Camera: Phoenix ICON (100° FOV). Pediatric retinal photograph (wide-field).
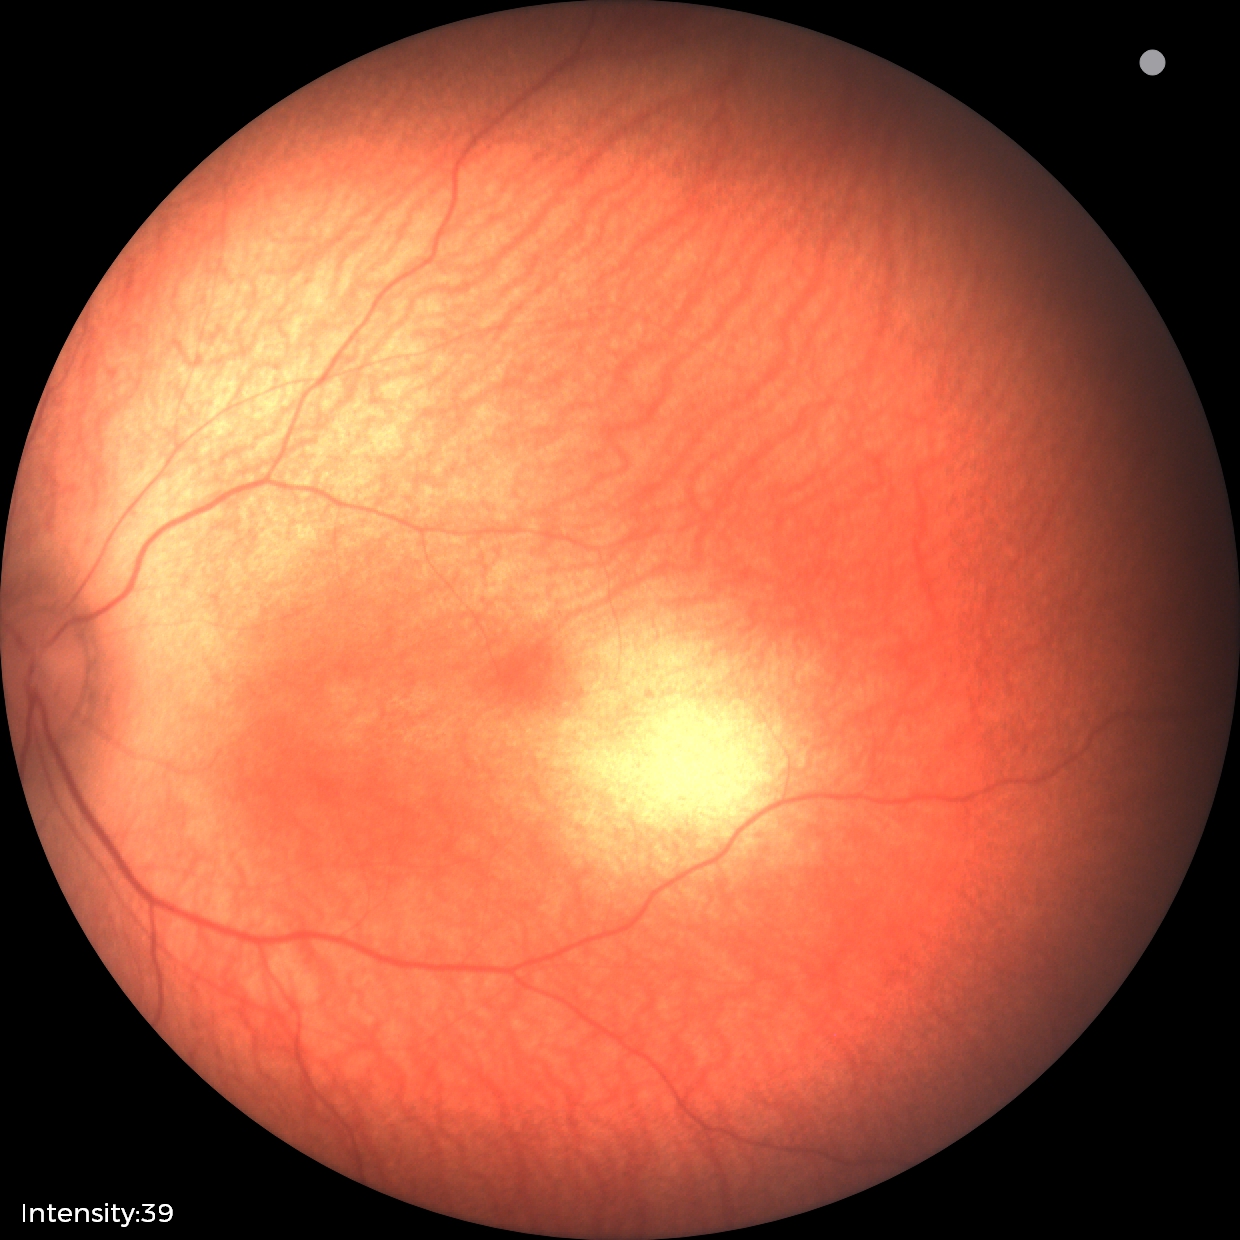
Screening examination diagnosed as physiological.